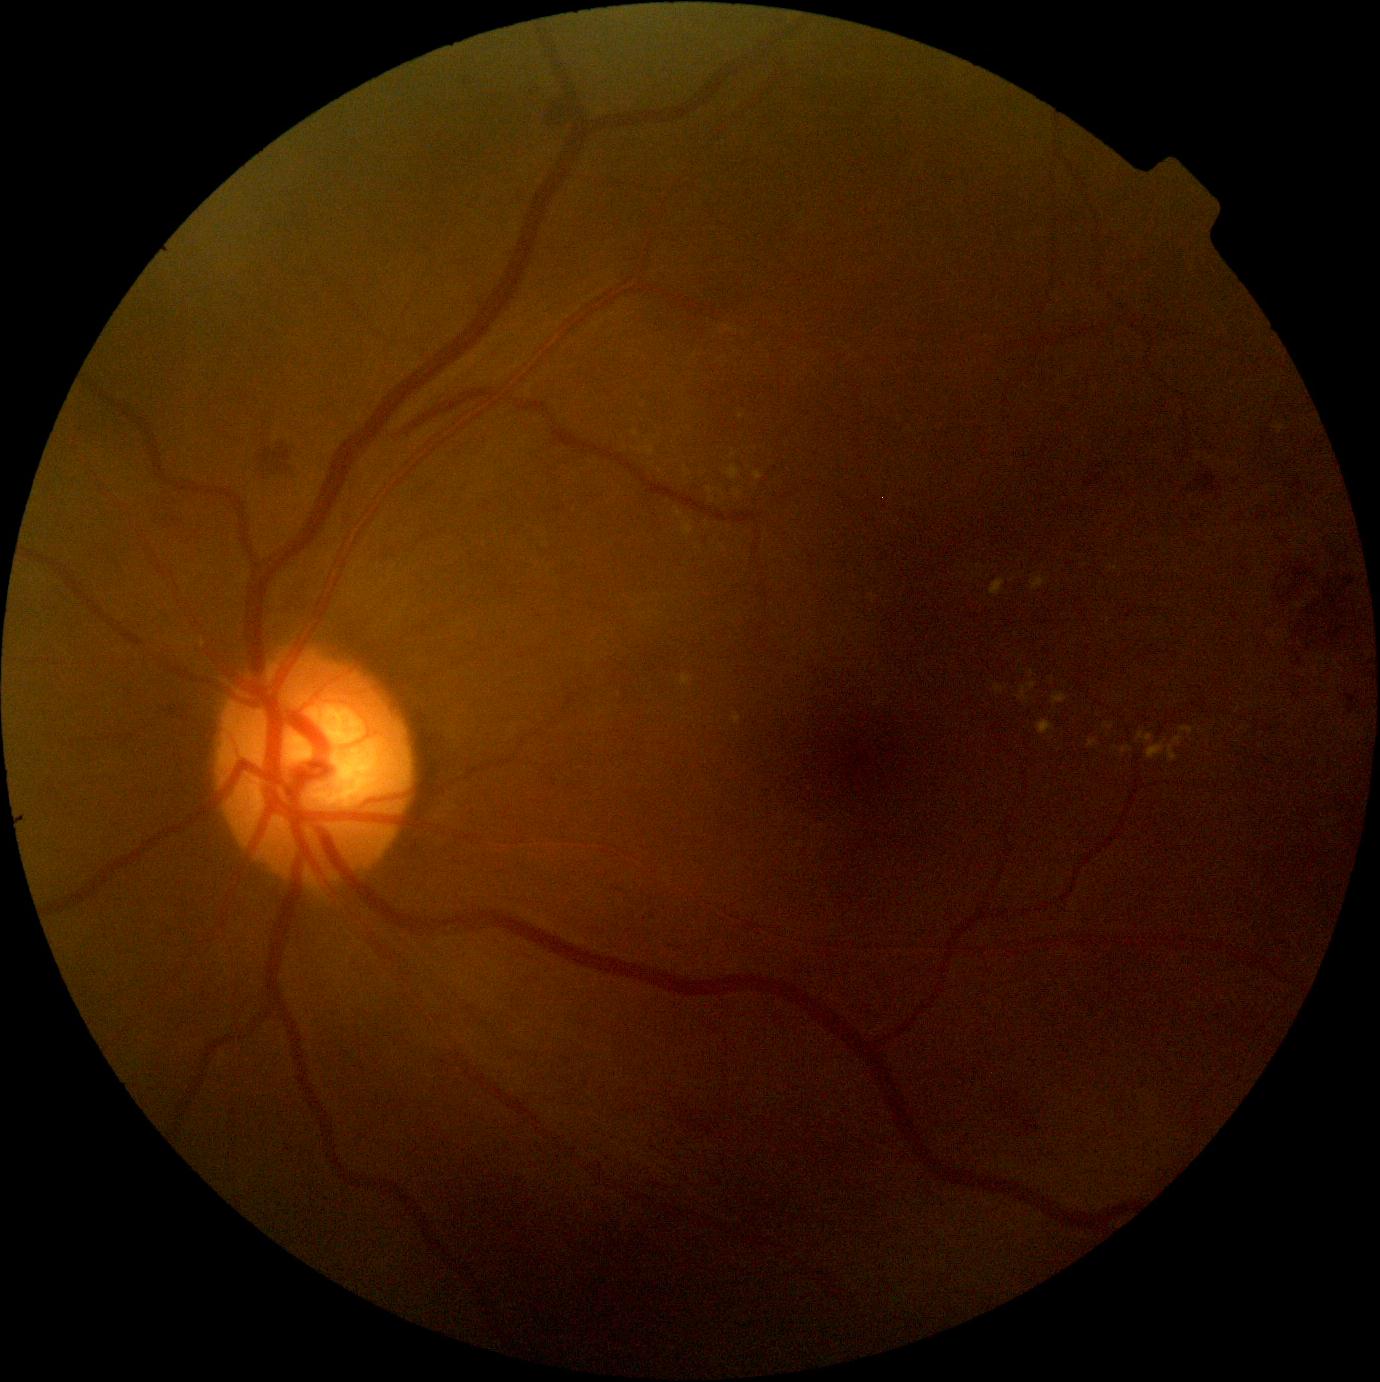
Diabetic retinopathy (DR) is moderate NPDR (grade 2)
Lesions identified (partial list):
hemorrhages (HEs) (more not shown): box(1348, 707, 1356, 714); box(258, 449, 273, 467); box(548, 99, 571, 123); box(1278, 594, 1287, 605); box(274, 444, 292, 472); box(1345, 694, 1357, 706)
Smaller HEs around pt(1285, 568); pt(1326, 642); pt(1299, 592); pt(1296, 588); pt(1310, 571); pt(1327, 591)
hard exudates (EXs) (more not shown): box(684, 469, 690, 478); box(726, 466, 740, 480); box(1121, 746, 1134, 755); box(681, 675, 692, 686); box(1147, 736, 1182, 761); box(754, 472, 763, 481); box(1031, 577, 1047, 590); box(1138, 732, 1154, 744); box(991, 578, 1006, 597); box(674, 508, 682, 519); box(1088, 740, 1100, 748)
Smaller EXs around pt(1109, 621); pt(741, 416); pt(733, 457); pt(722, 547); pt(641, 450); pt(737, 494)
microaneurysms (MAs) (more not shown): box(464, 77, 470, 87); box(598, 1163, 603, 1172); box(1024, 1121, 1039, 1134); box(1014, 1106, 1020, 1114)
Smaller MAs around pt(532, 93); pt(619, 890); pt(363, 1069)
soft exudates (SEs): none detected